2352 x 1568 pixels:
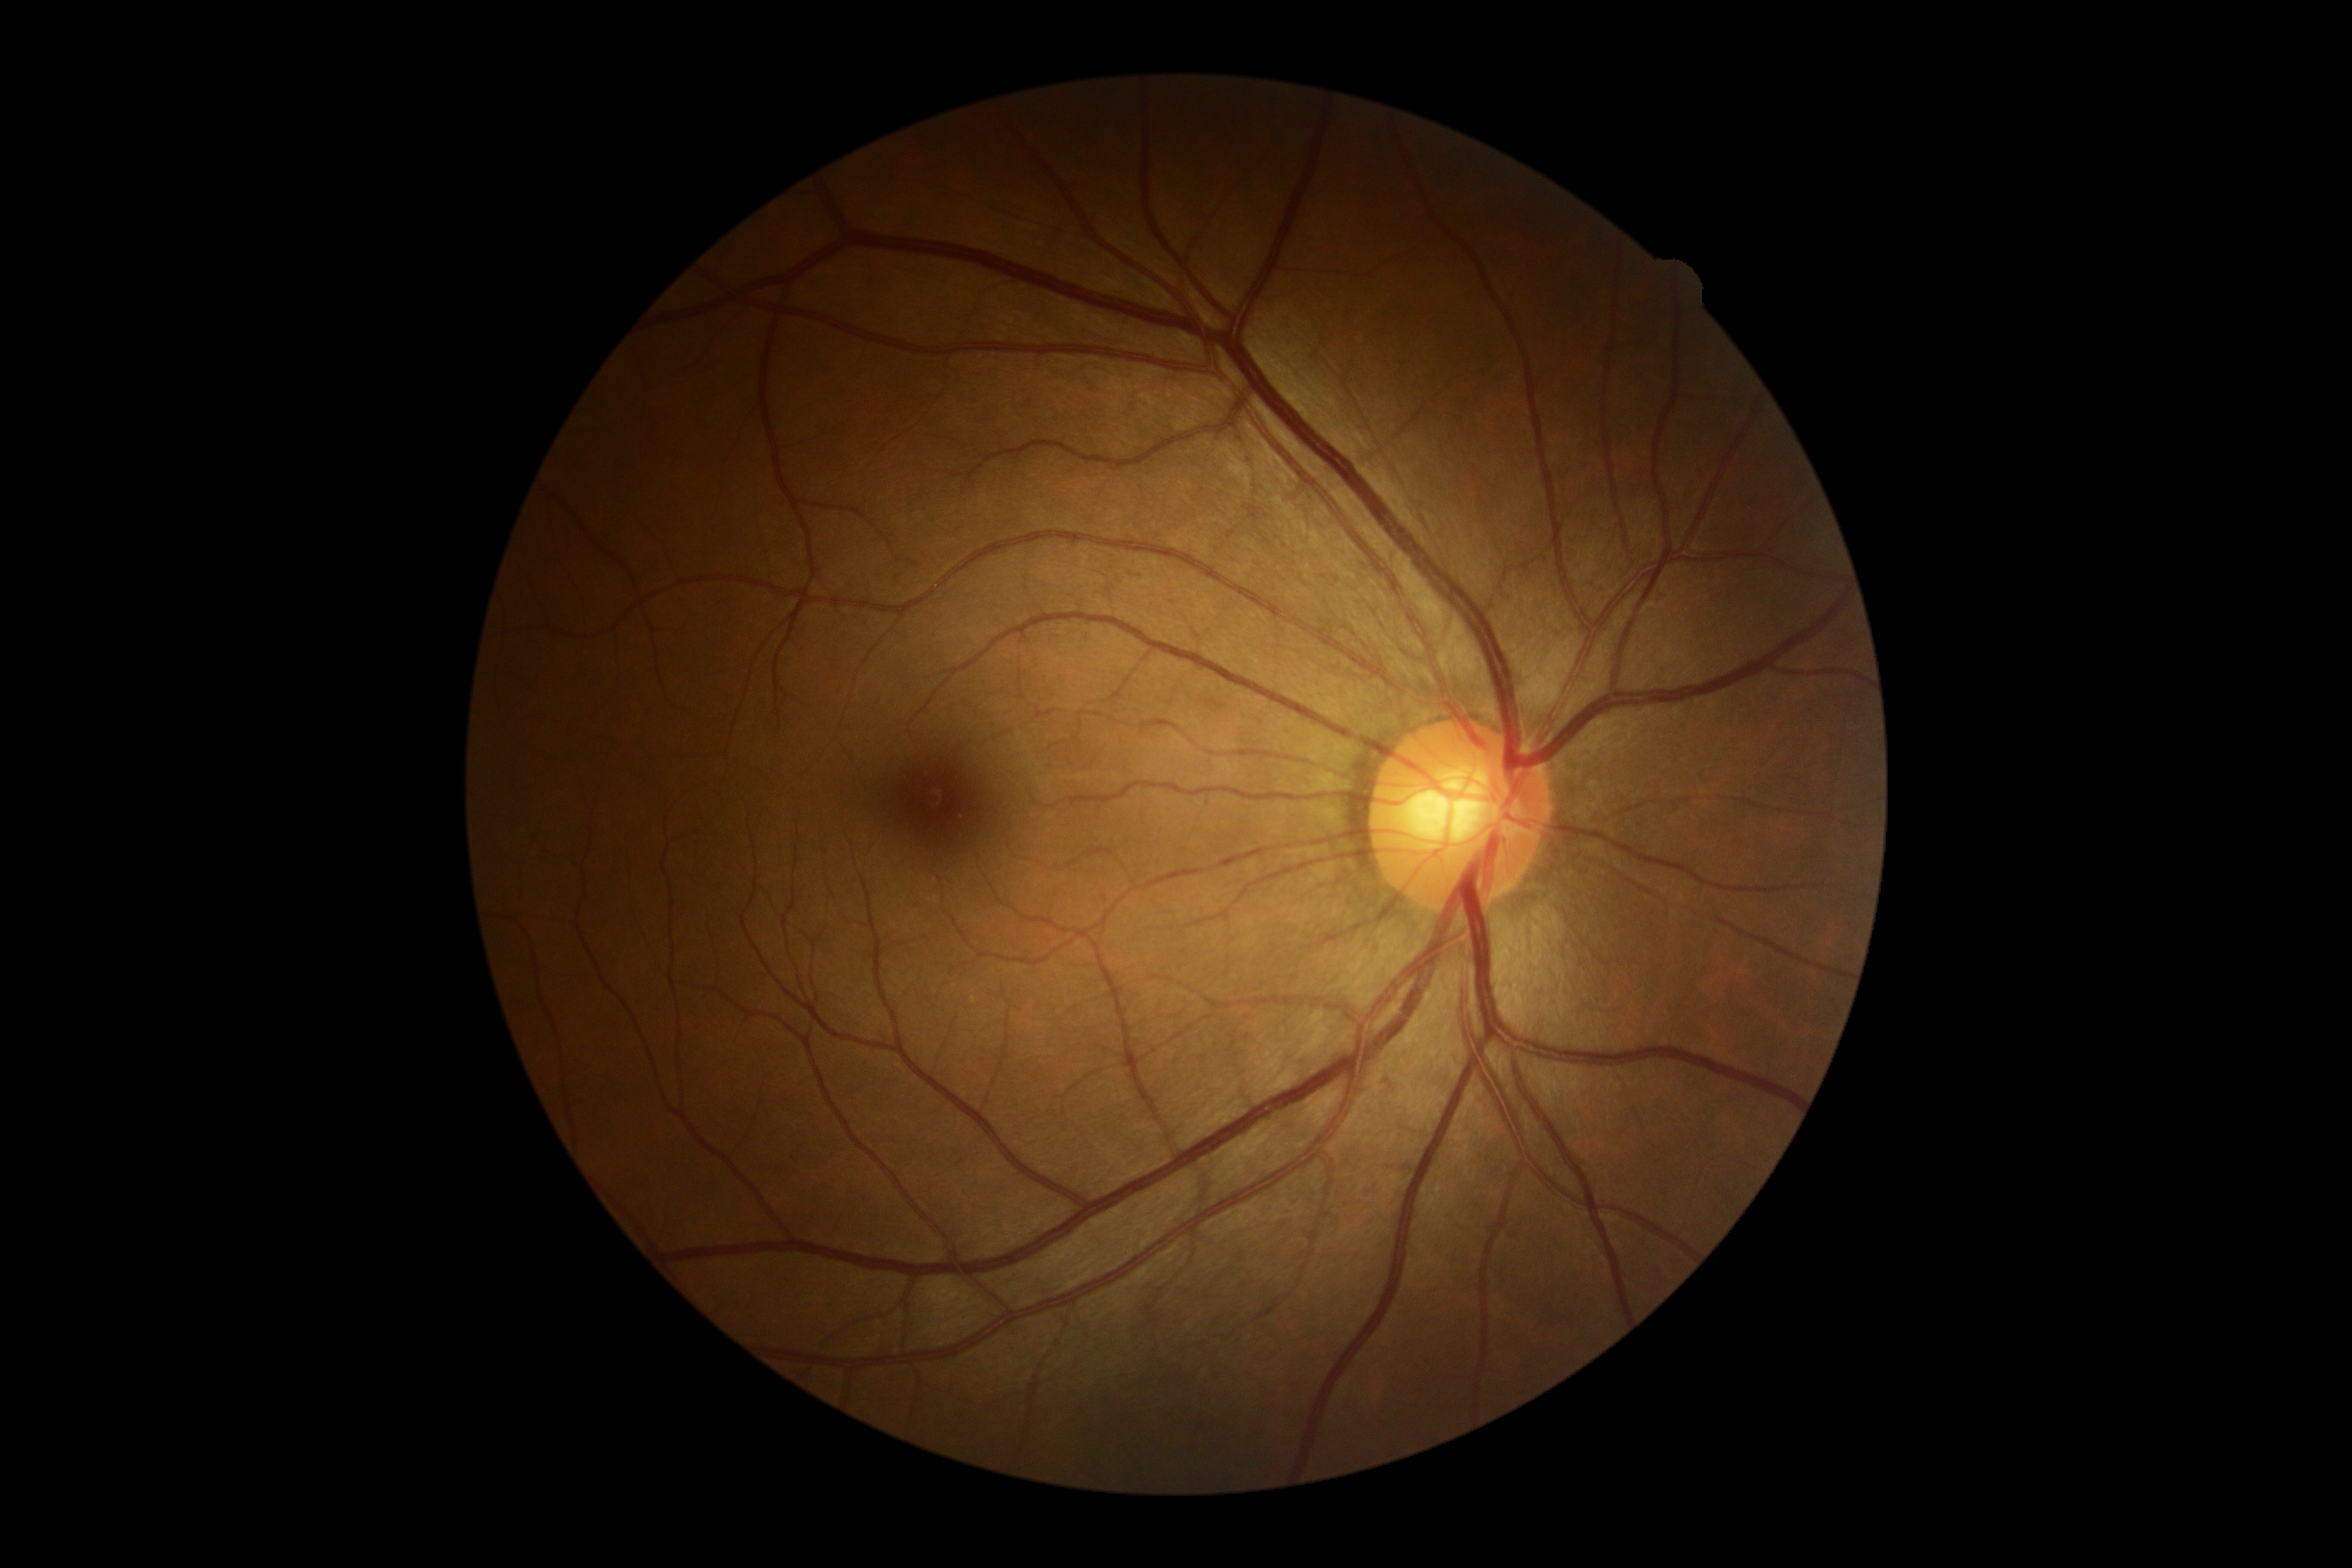 DR impression: no DR findings
diabetic retinopathy (DR): grade 0 (no apparent retinopathy) — no visible signs of diabetic retinopathy